2352 by 1568 pixels:
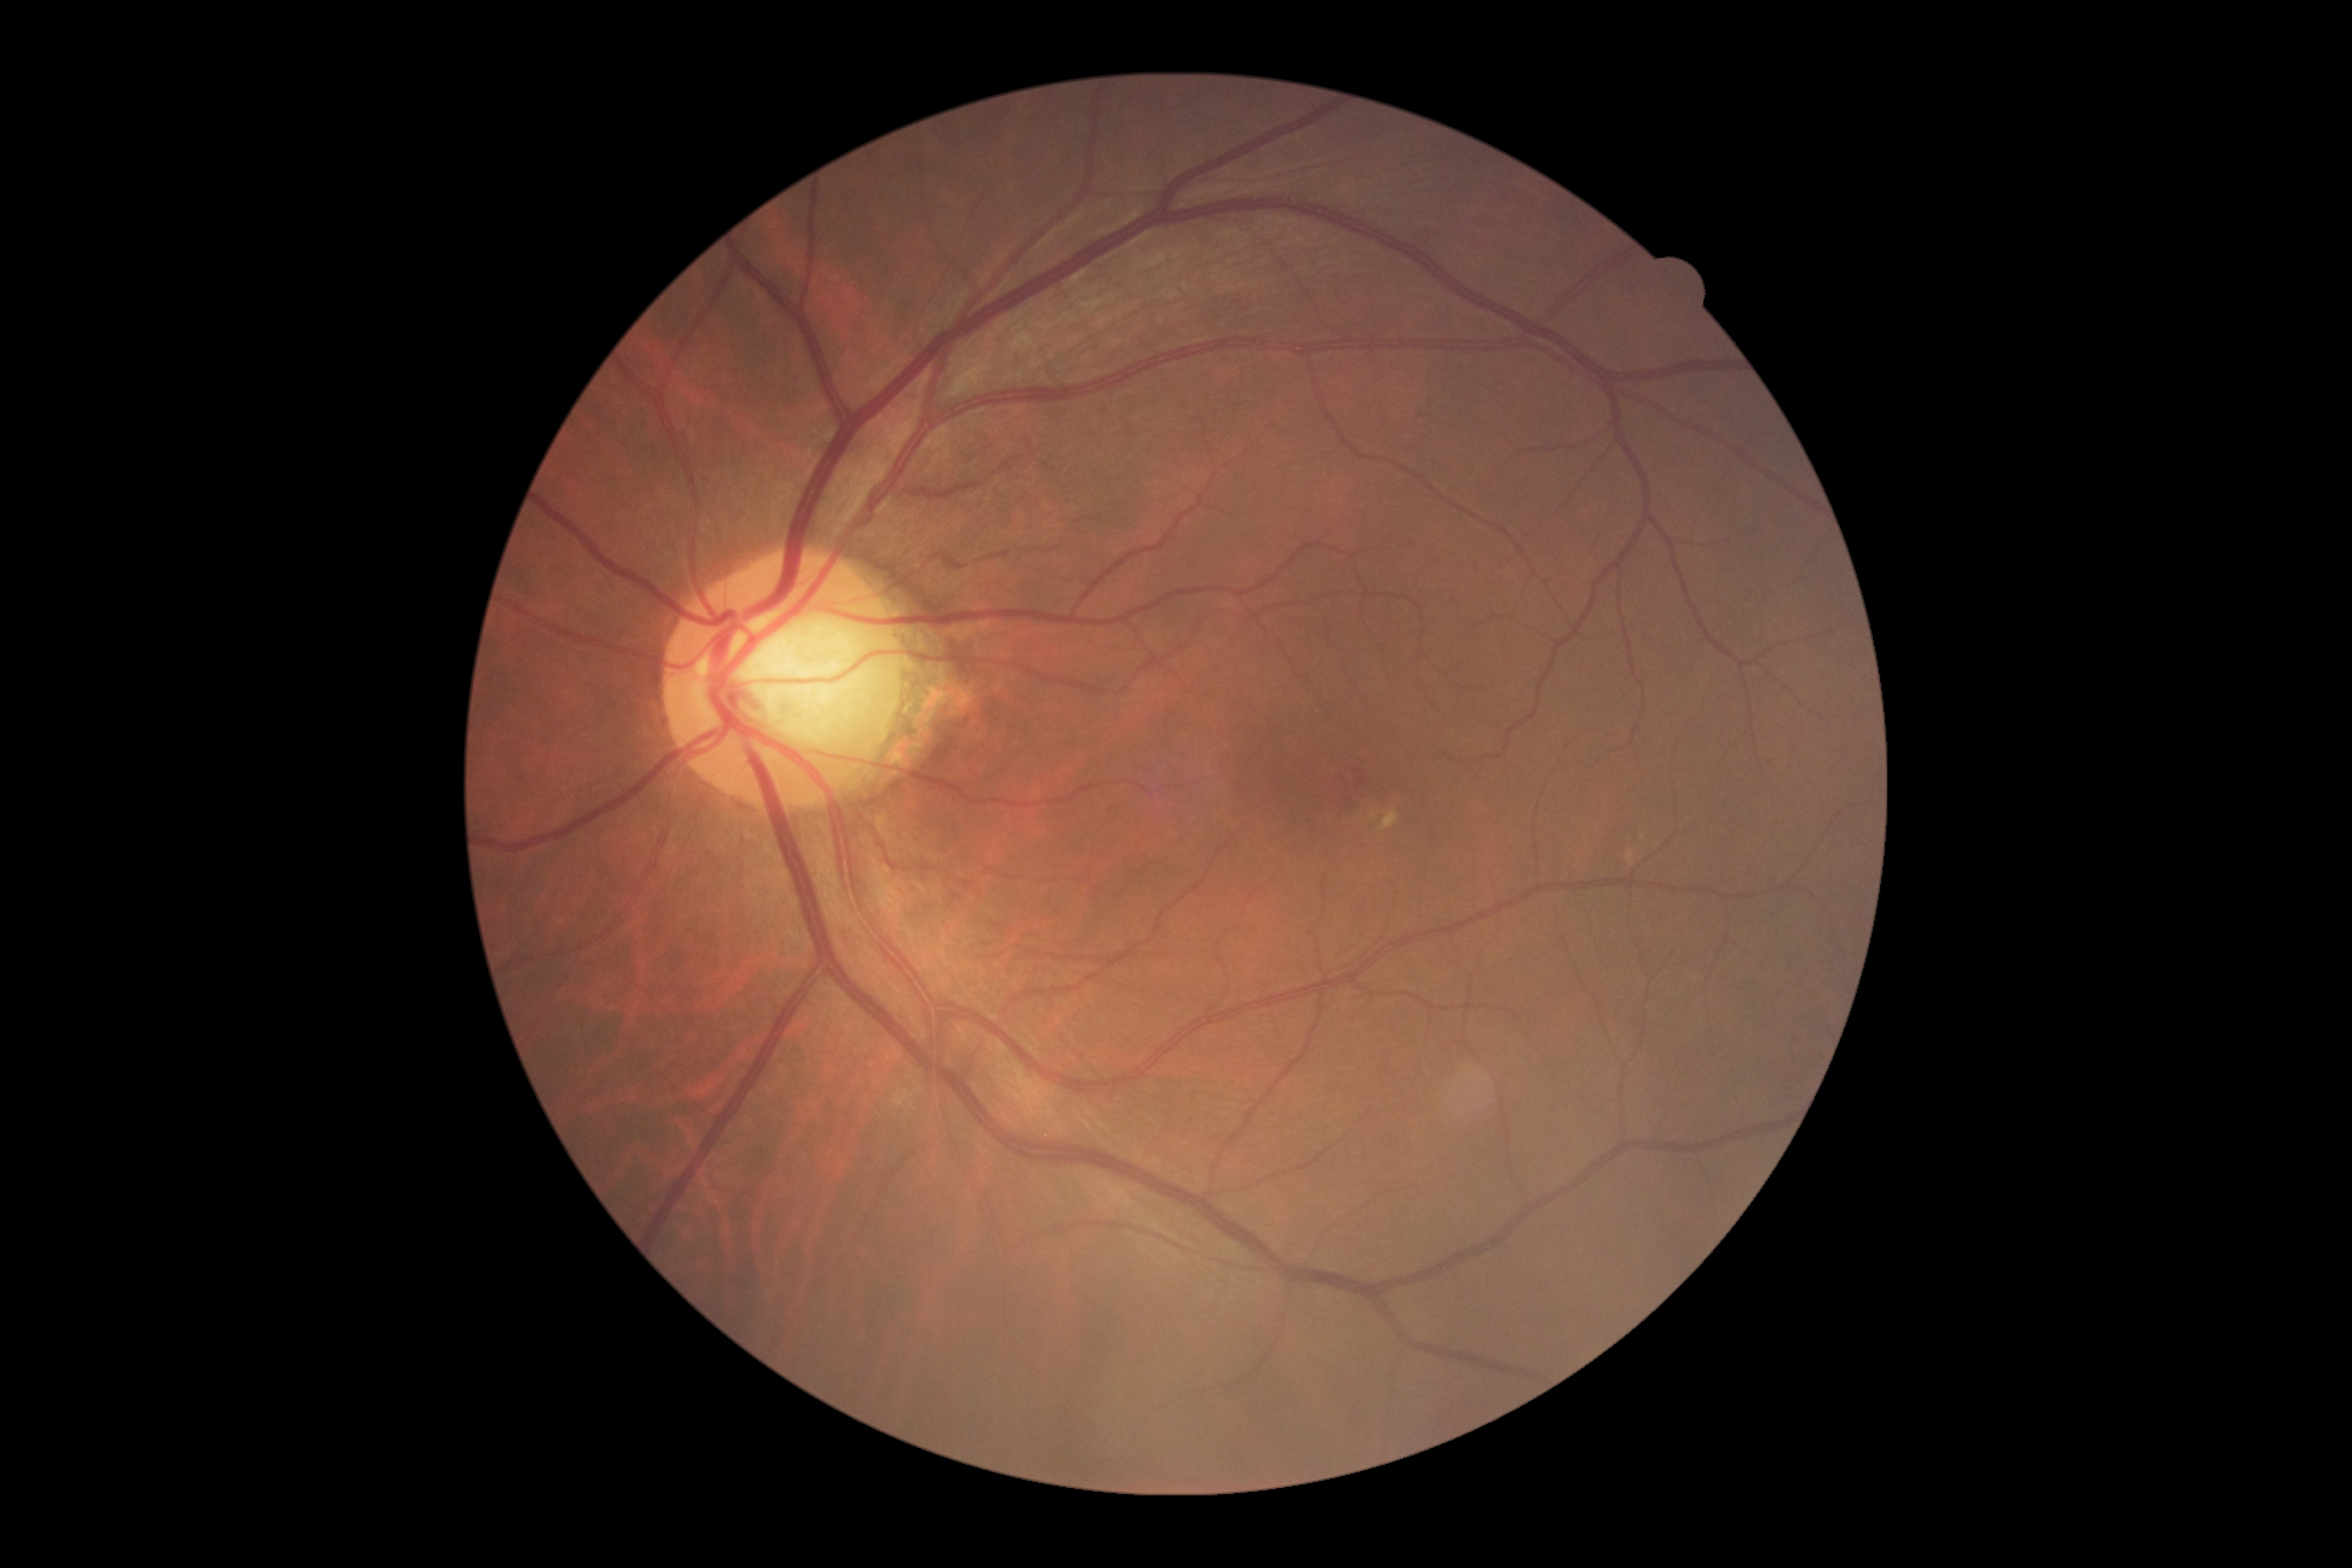
{
  "dr_grade": "0",
  "dr_impression": "no DR findings"
}